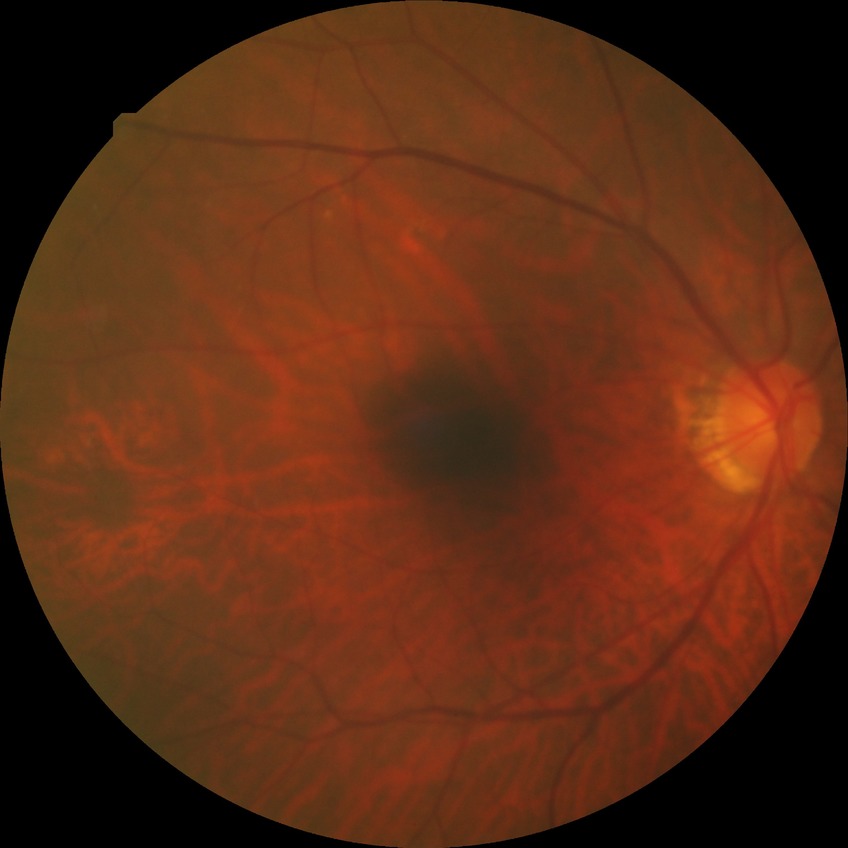

Diabetic retinopathy (DR): NDR (no diabetic retinopathy).